Color fundus photograph, 2352 x 1568 pixels, 45-degree field of view: 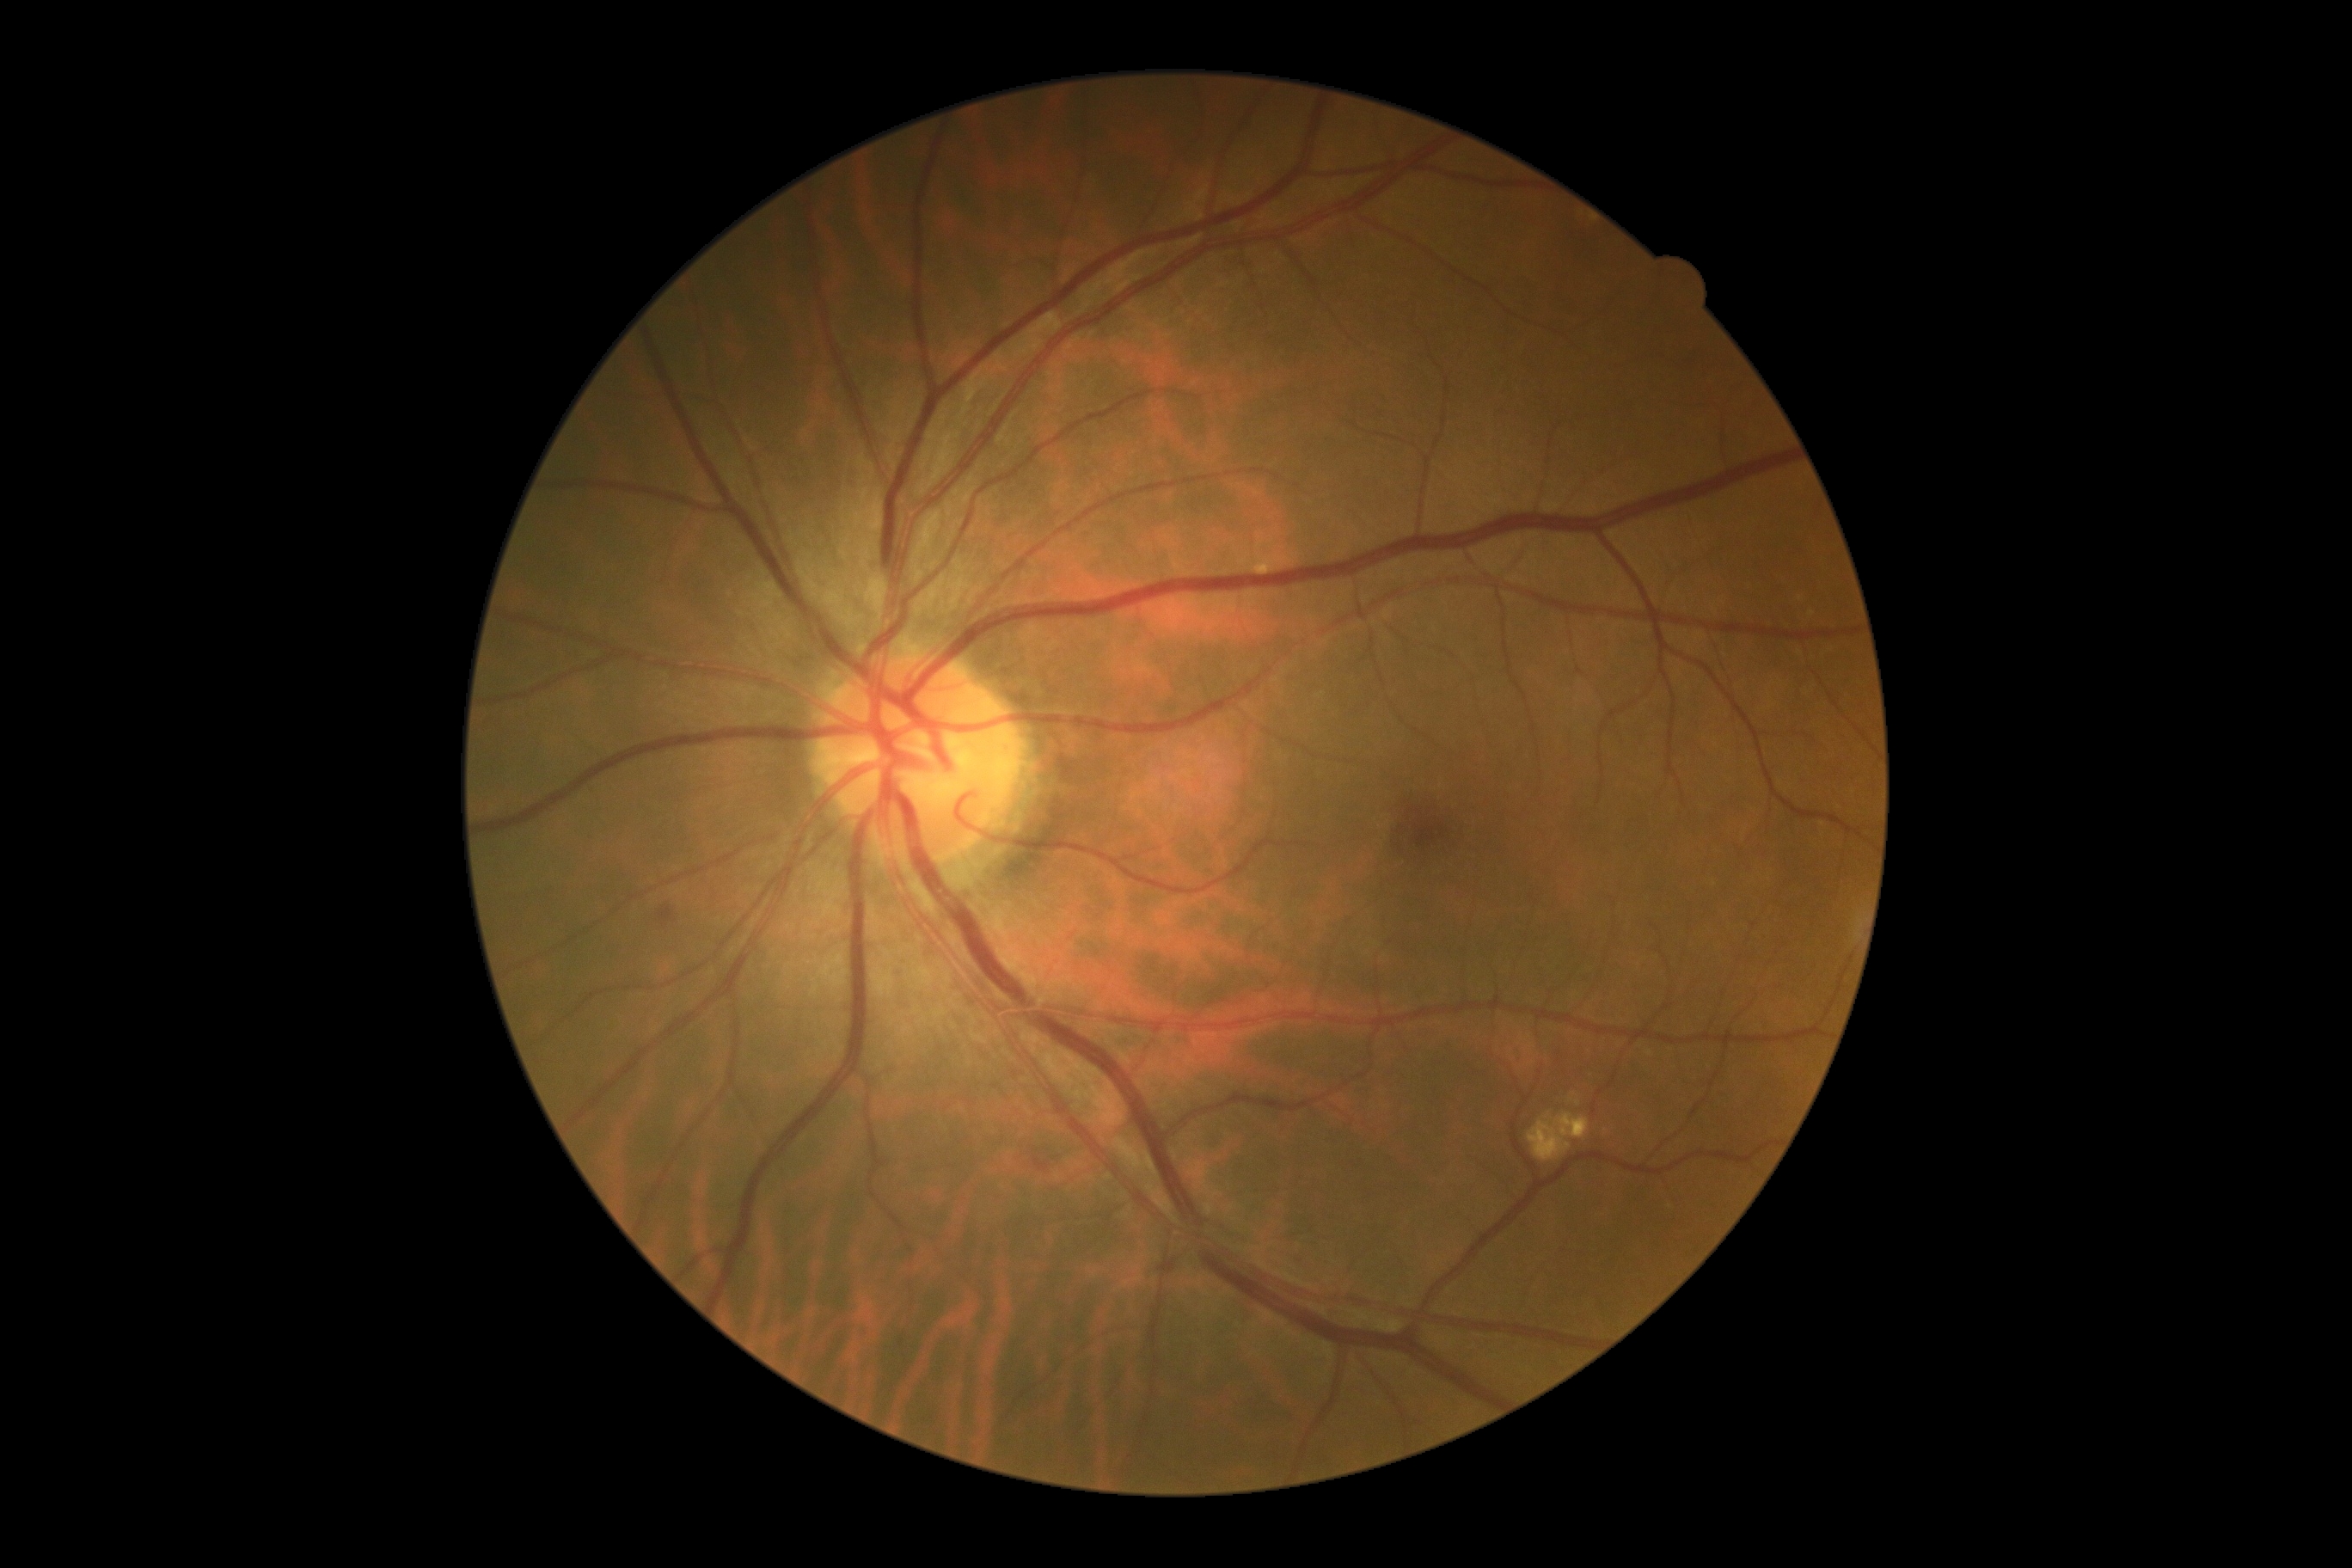 Findings:
- retinopathy — 2